No pharmacologic dilation. Acquired with a NIDEK AFC-230 — 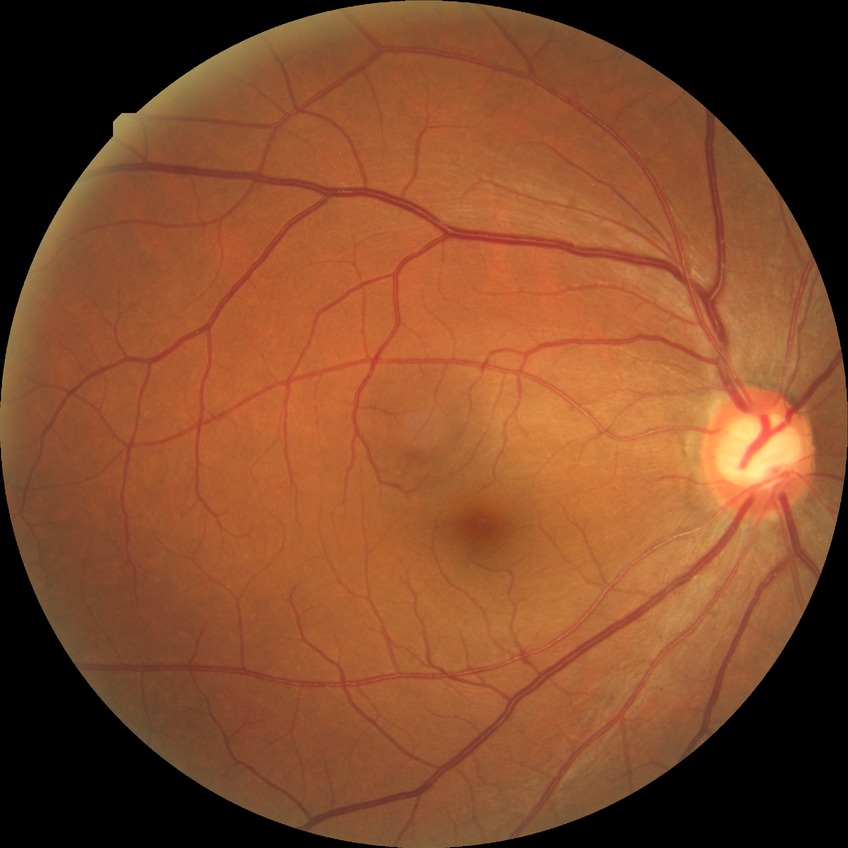 Diabetic retinopathy (DR): no diabetic retinopathy (NDR).